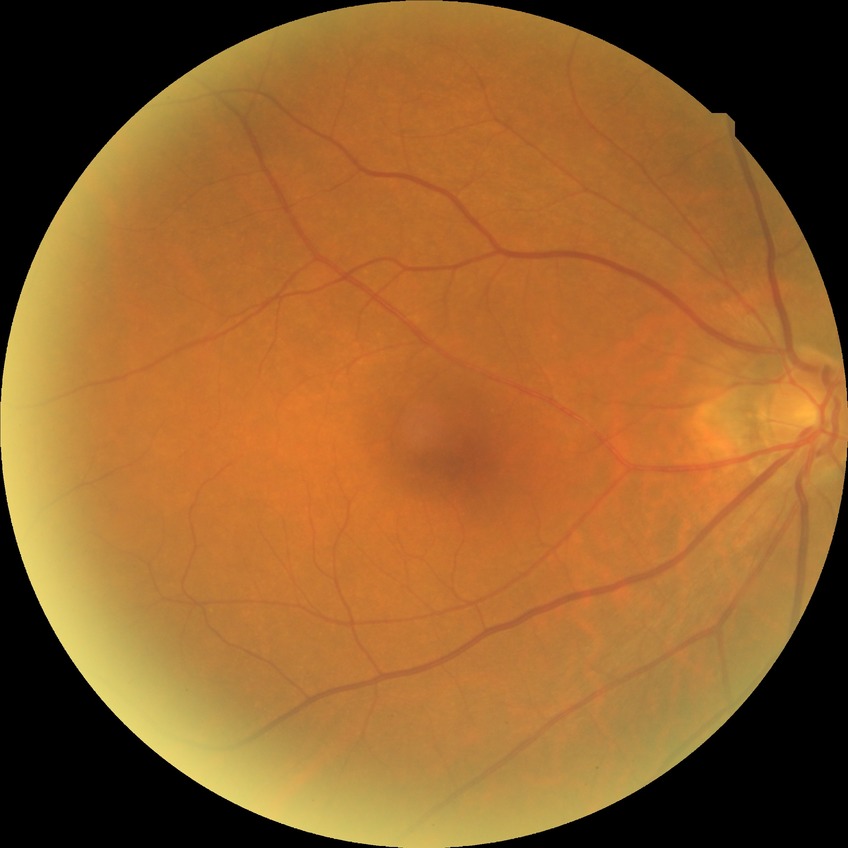 Diabetic retinopathy (DR): no diabetic retinopathy (NDR).